Pediatric wide-field fundus photograph.
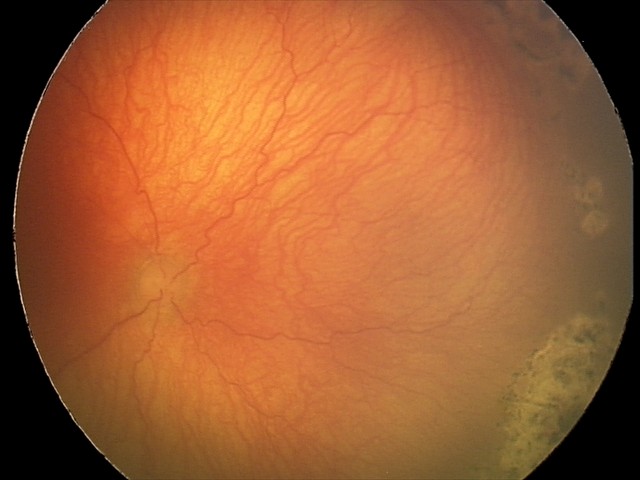

Examination diagnosed as aggressive retinopathy of prematurity.